Pediatric retinal photograph (wide-field):
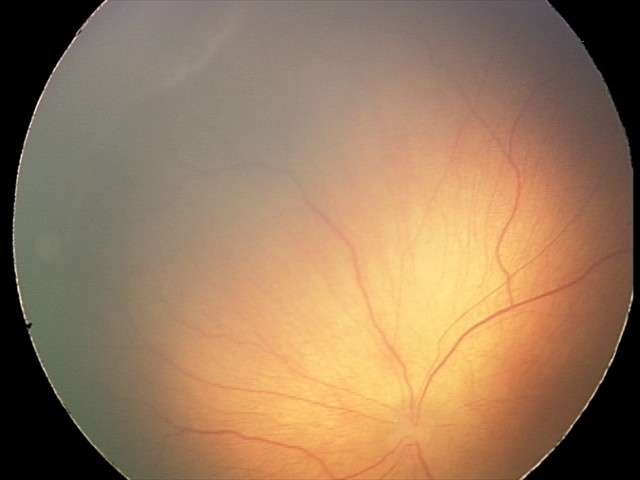 Screening series with retinopathy of prematurity stage 2 — ridge with height and width at the demarcation line.
Plus disease absent.